45° FOV, fundus photo
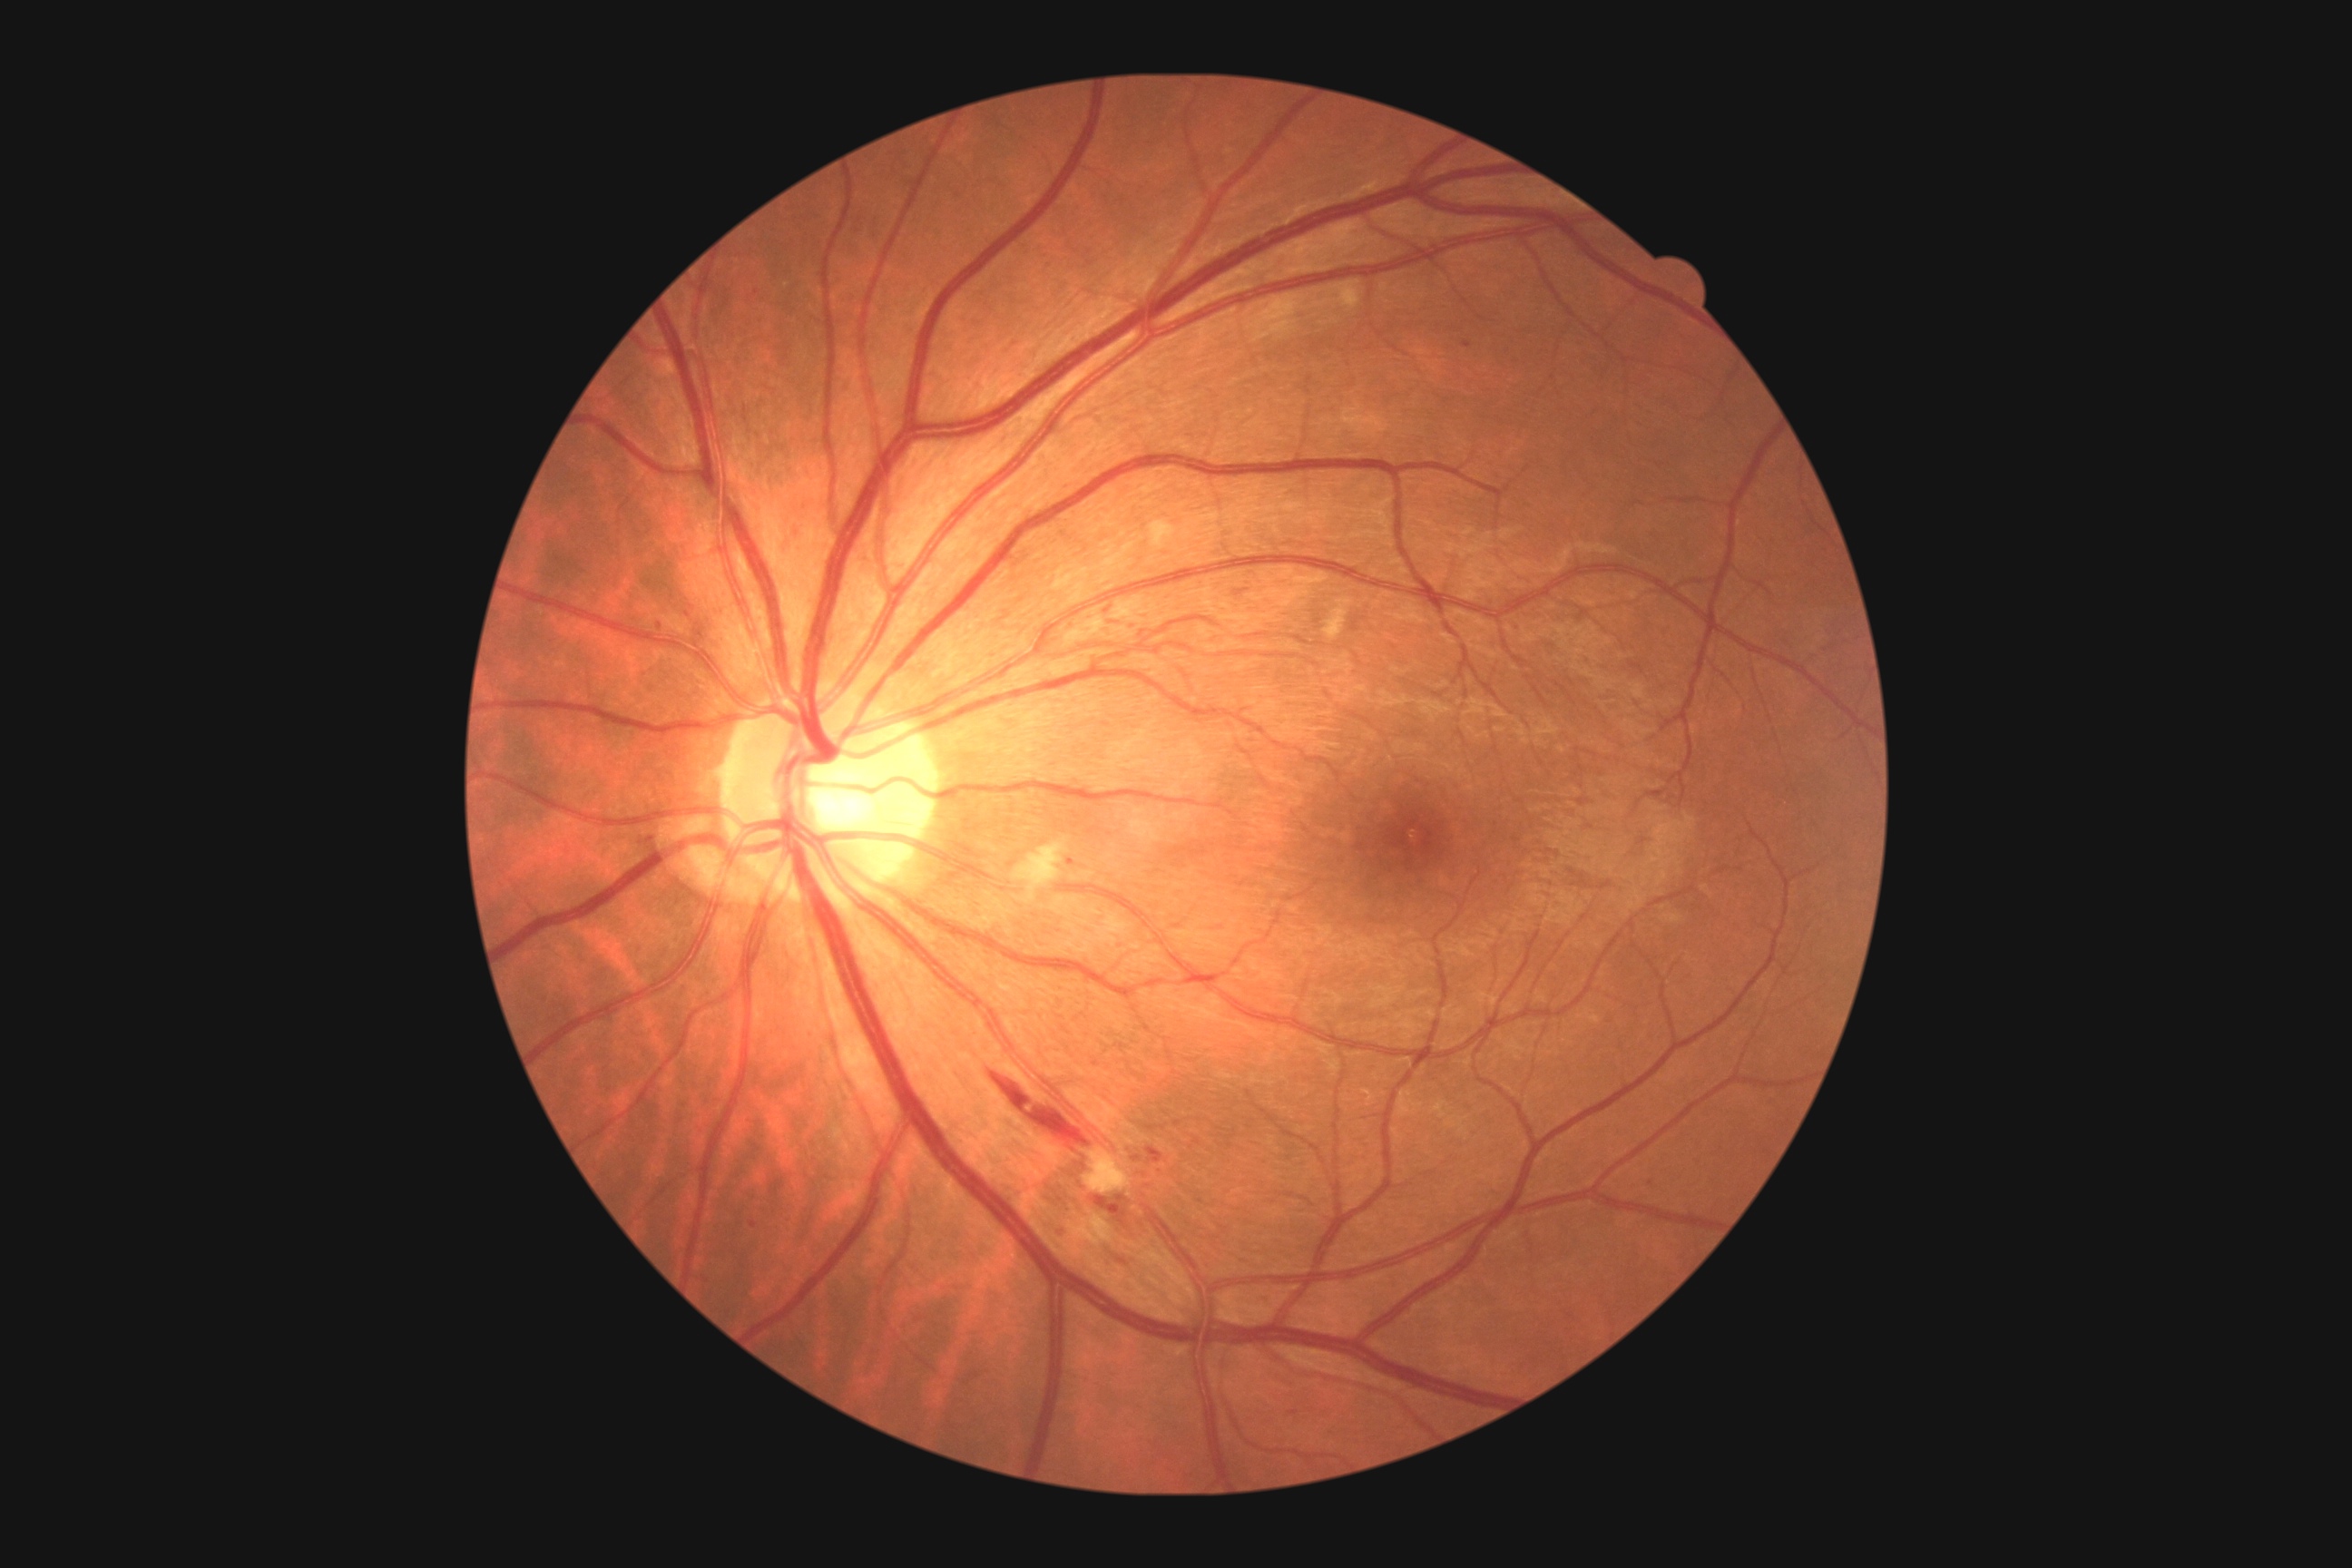   dr_grade: grade 2